No pharmacologic dilation: 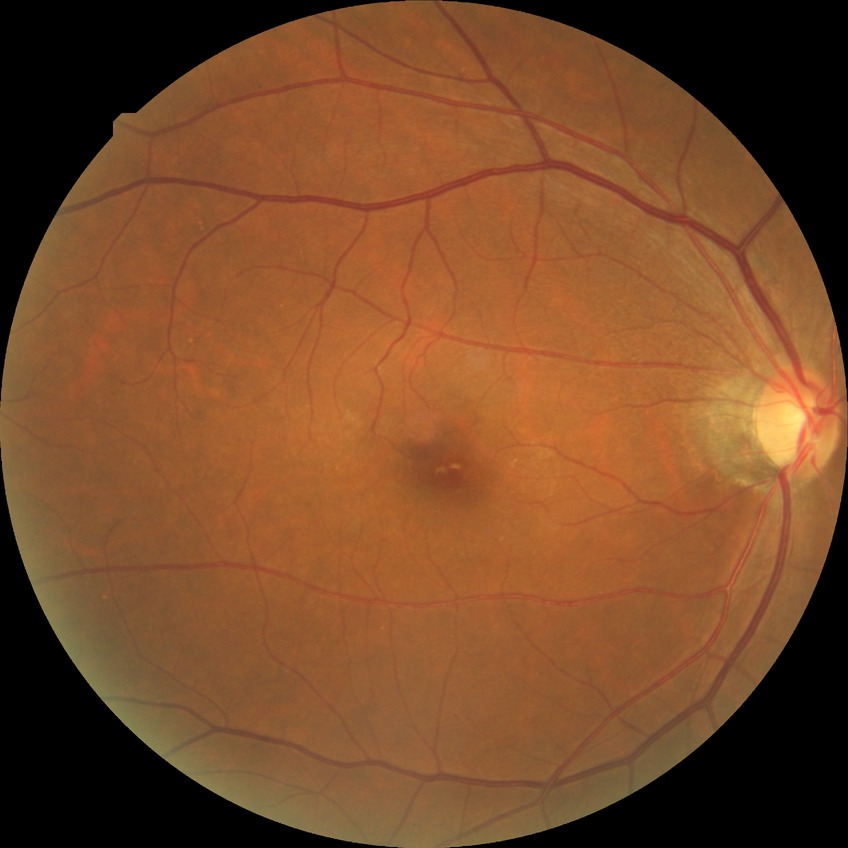 Diabetic retinopathy severity: no diabetic retinopathy.